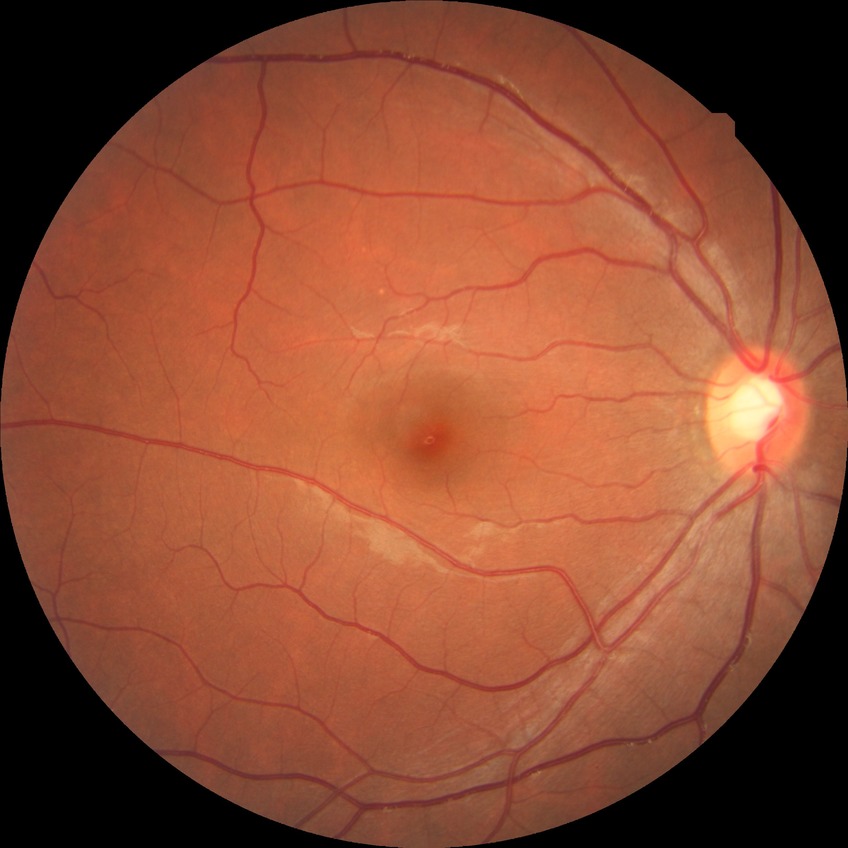

DR impression: no apparent DR, modified Davis grade: NDR.